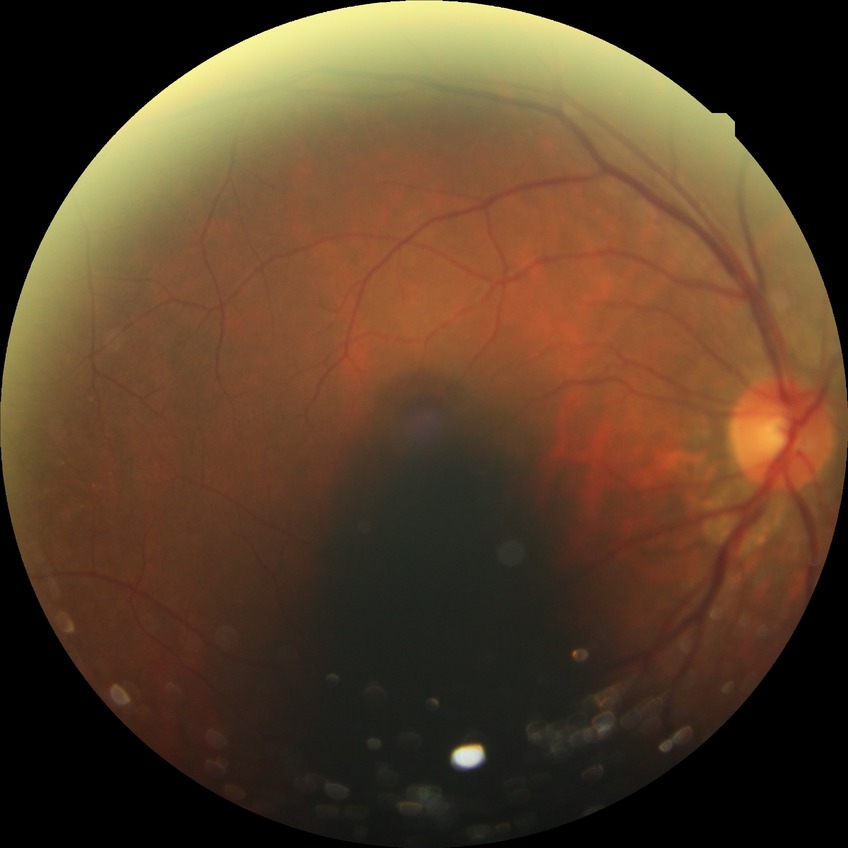

Diabetic retinopathy (DR) is NDR (no diabetic retinopathy).